Retinal fundus photograph, FOV: 45 degrees, 2352x1568px — 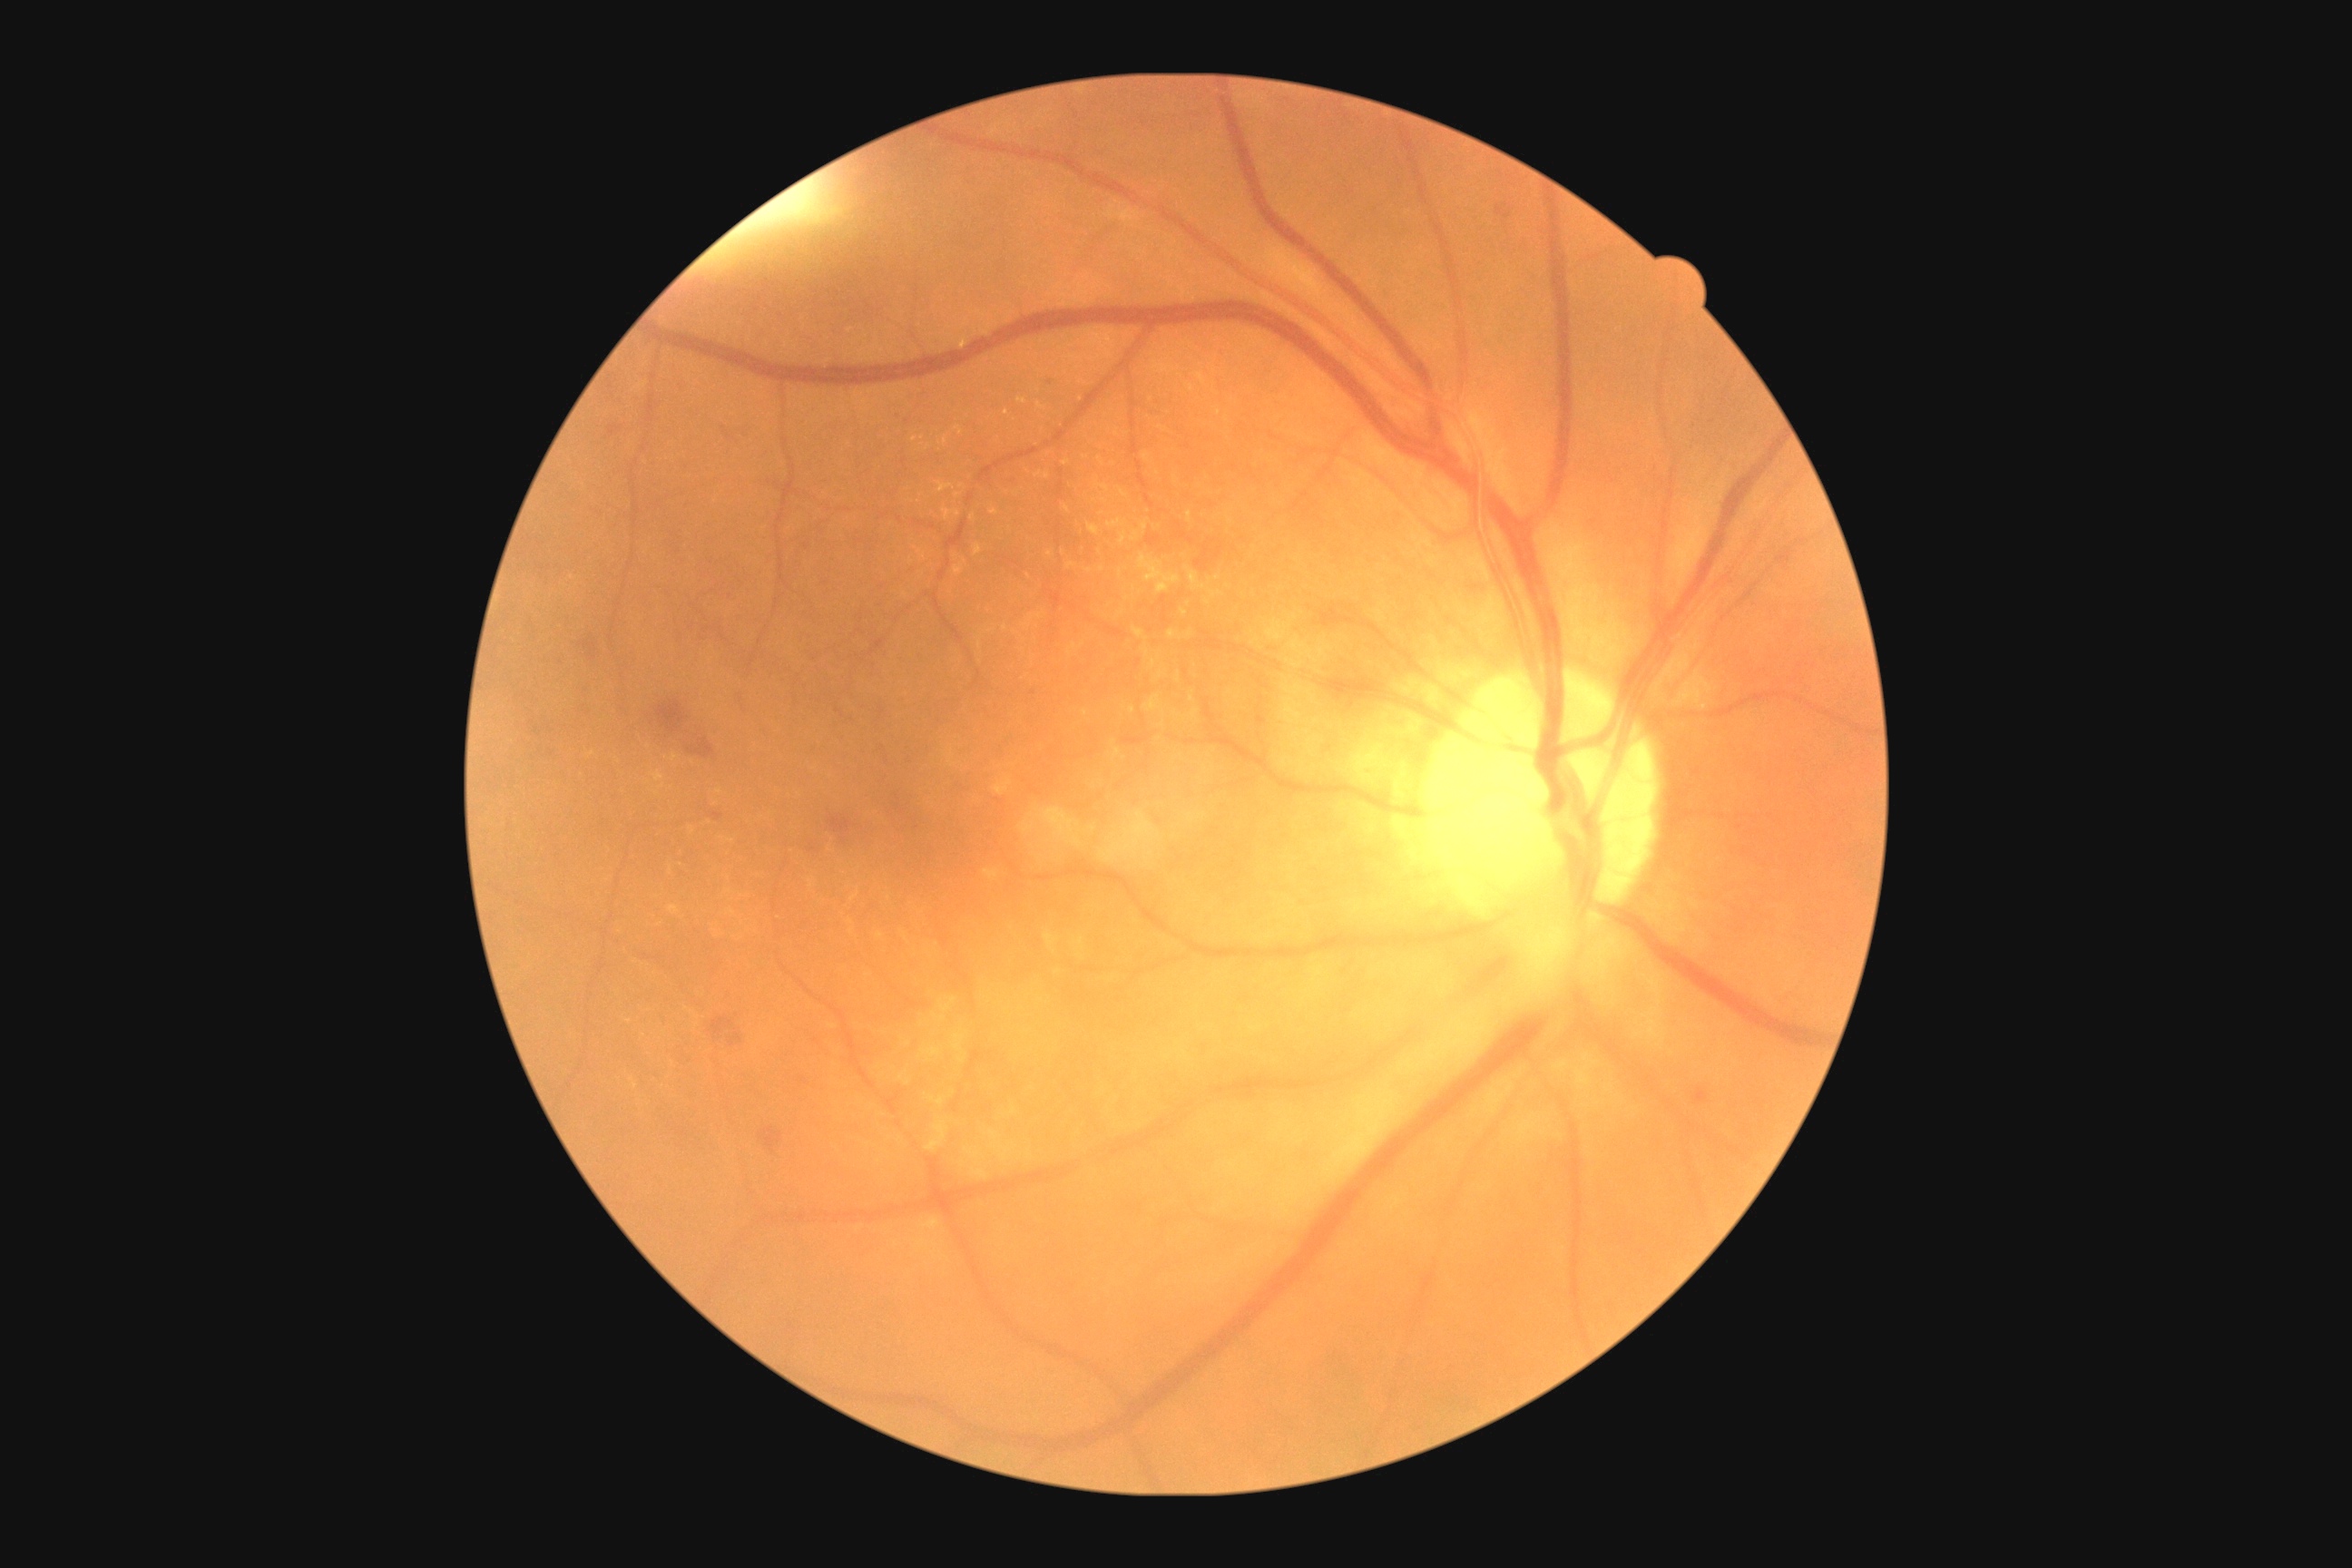
Findings:
• diabetic retinopathy (DR): grade 2